Woman · 39-year-old patient: 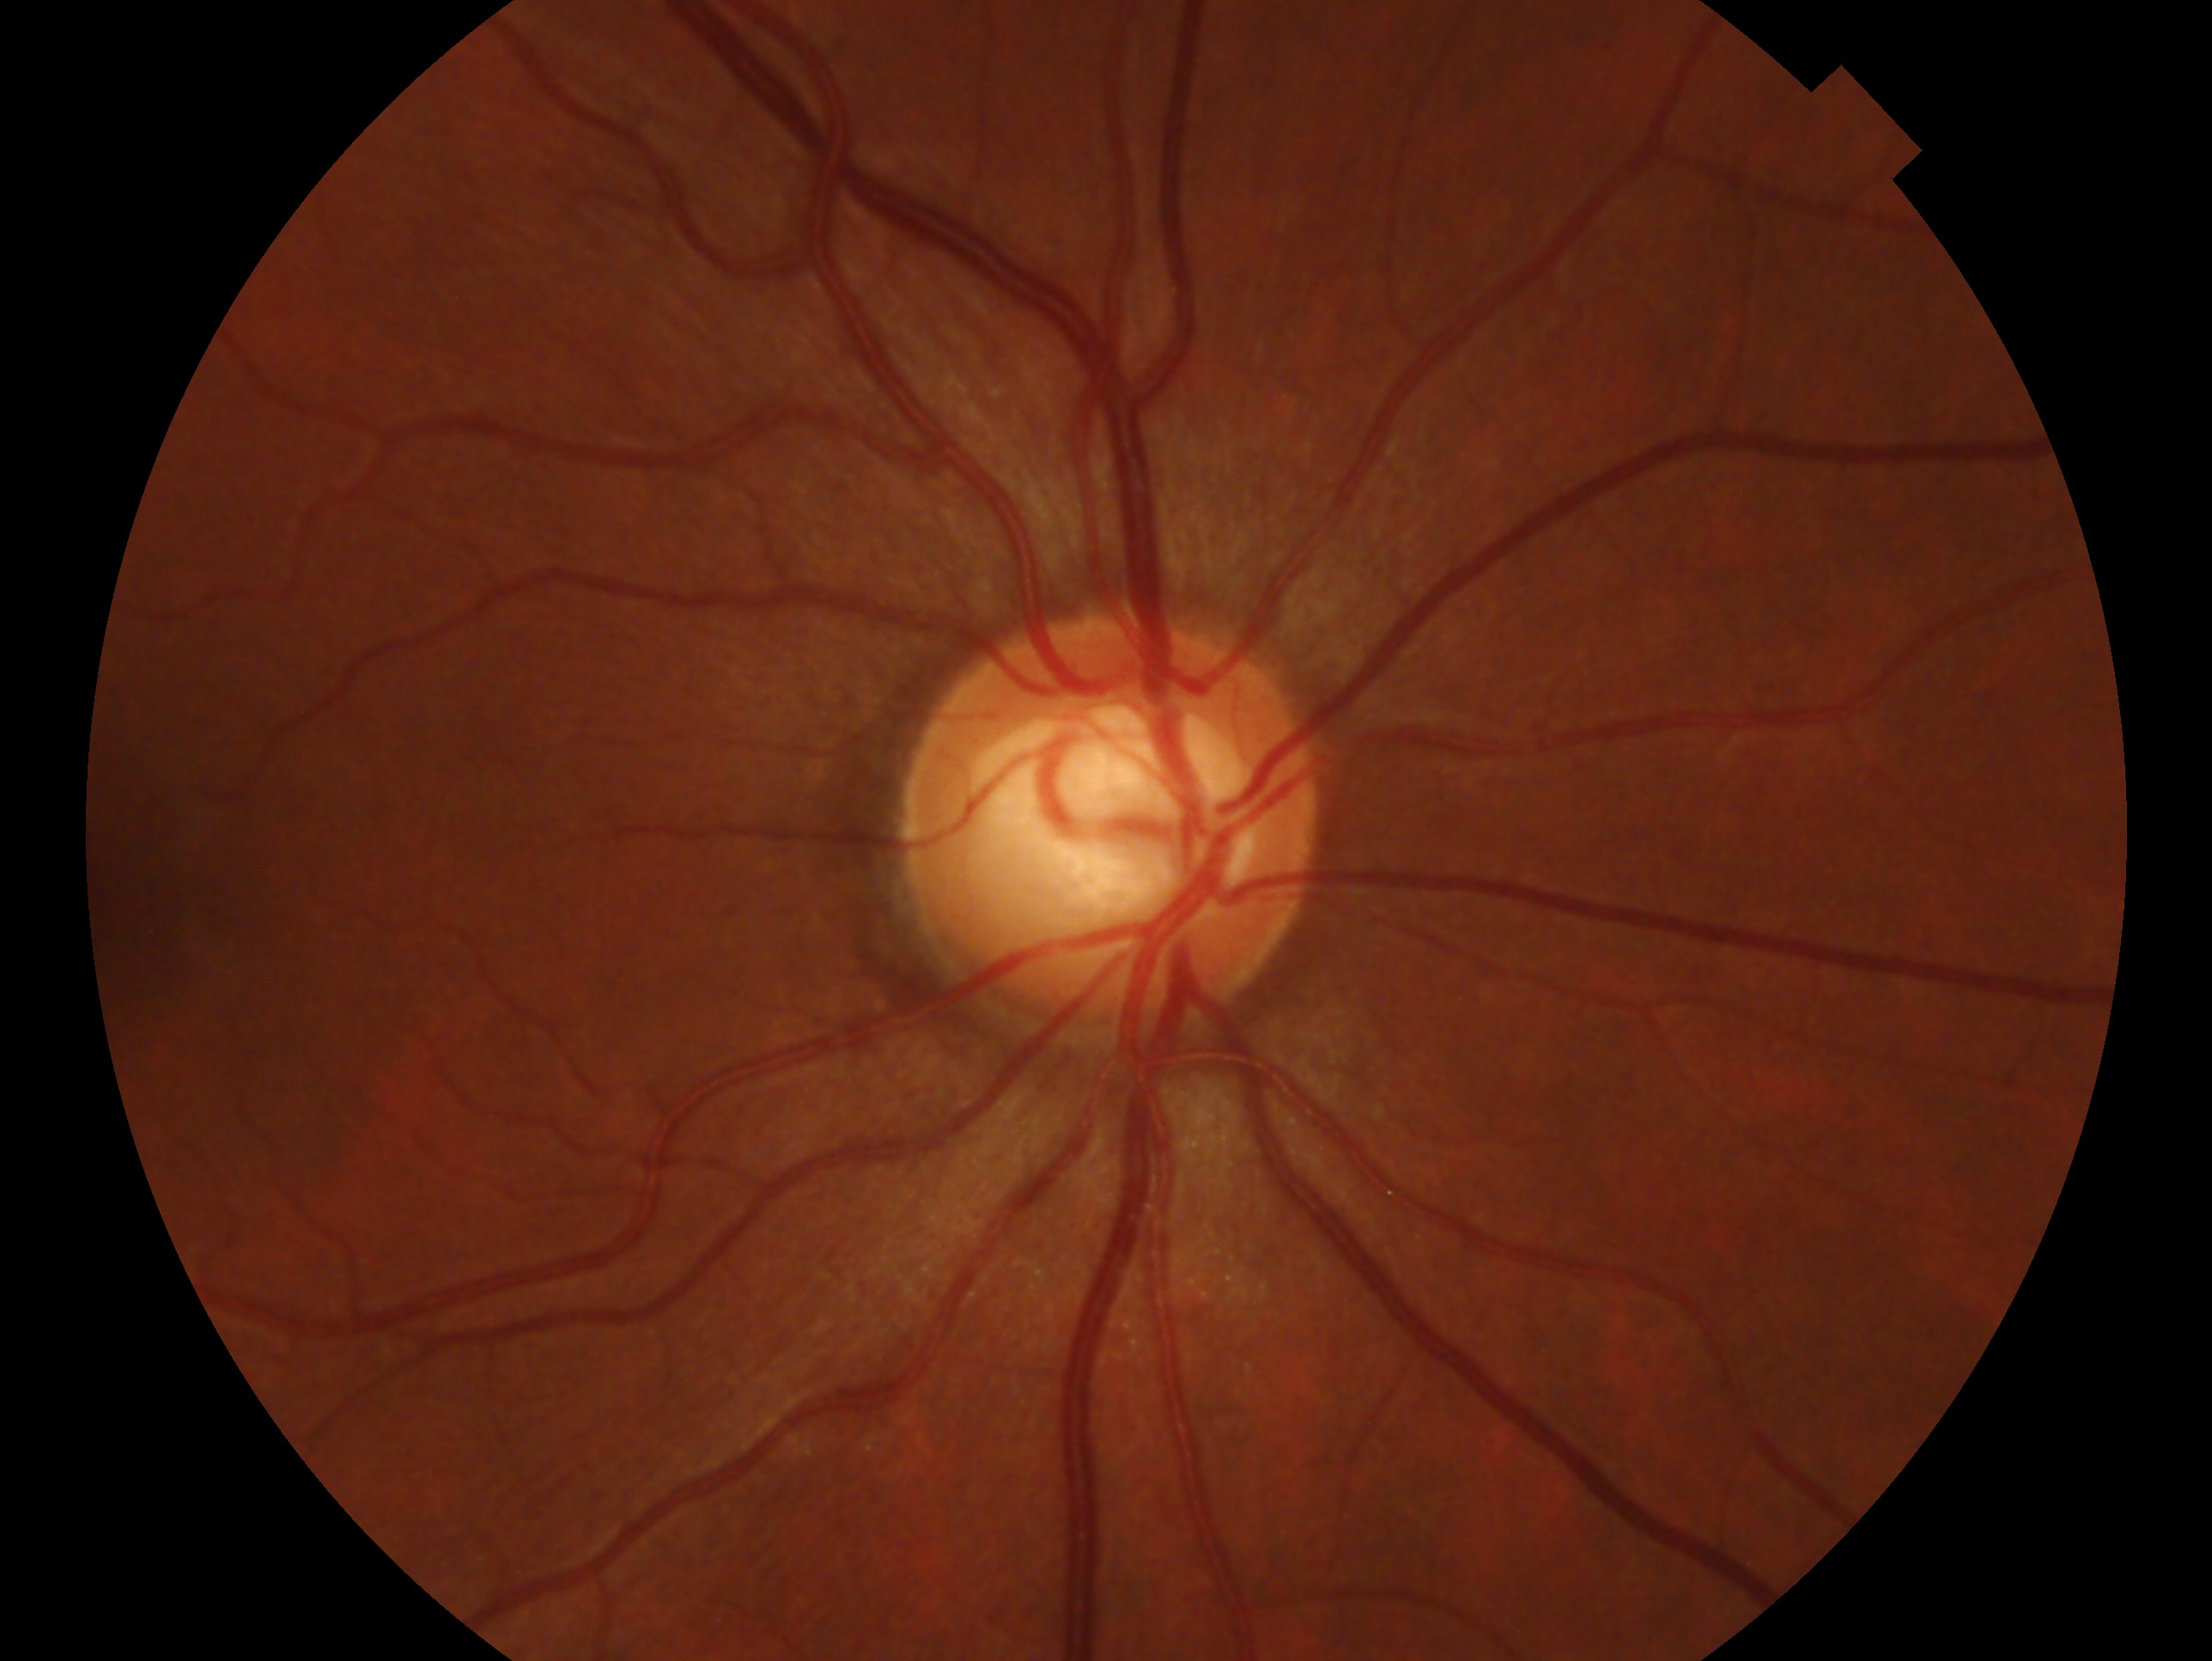 This is the right eye.
Glaucoma assessment: no glaucomatous findings.